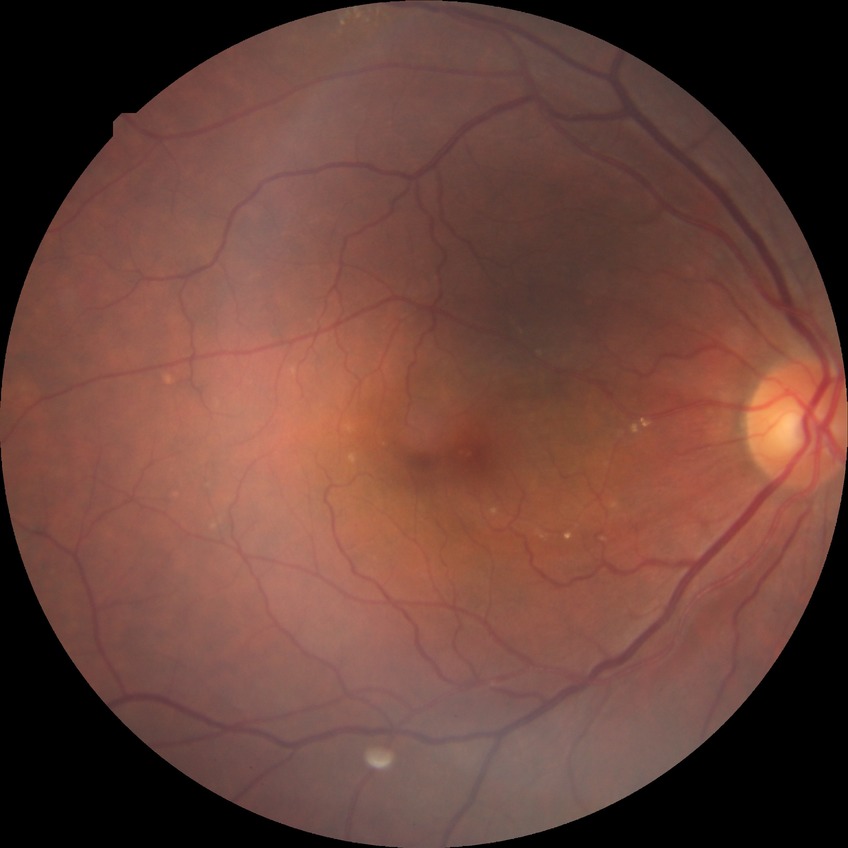
Assessment:
- diabetic retinopathy (DR) — NDR (no diabetic retinopathy)